Captured with the Clarity RetCam 3 (130° field of view); infant wide-field retinal image — 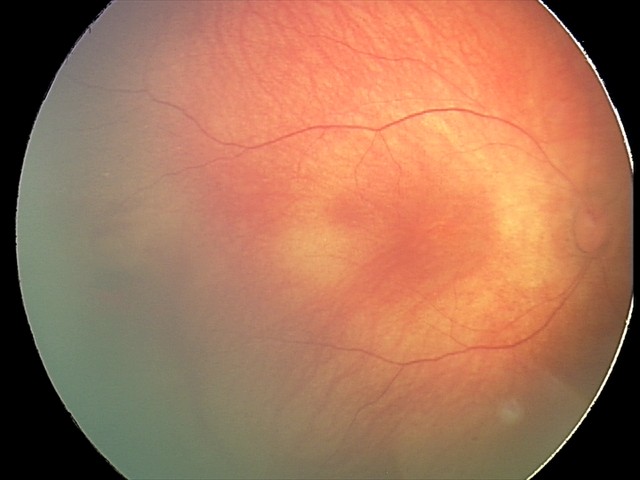
Series diagnosed as retinal hemorrhages.